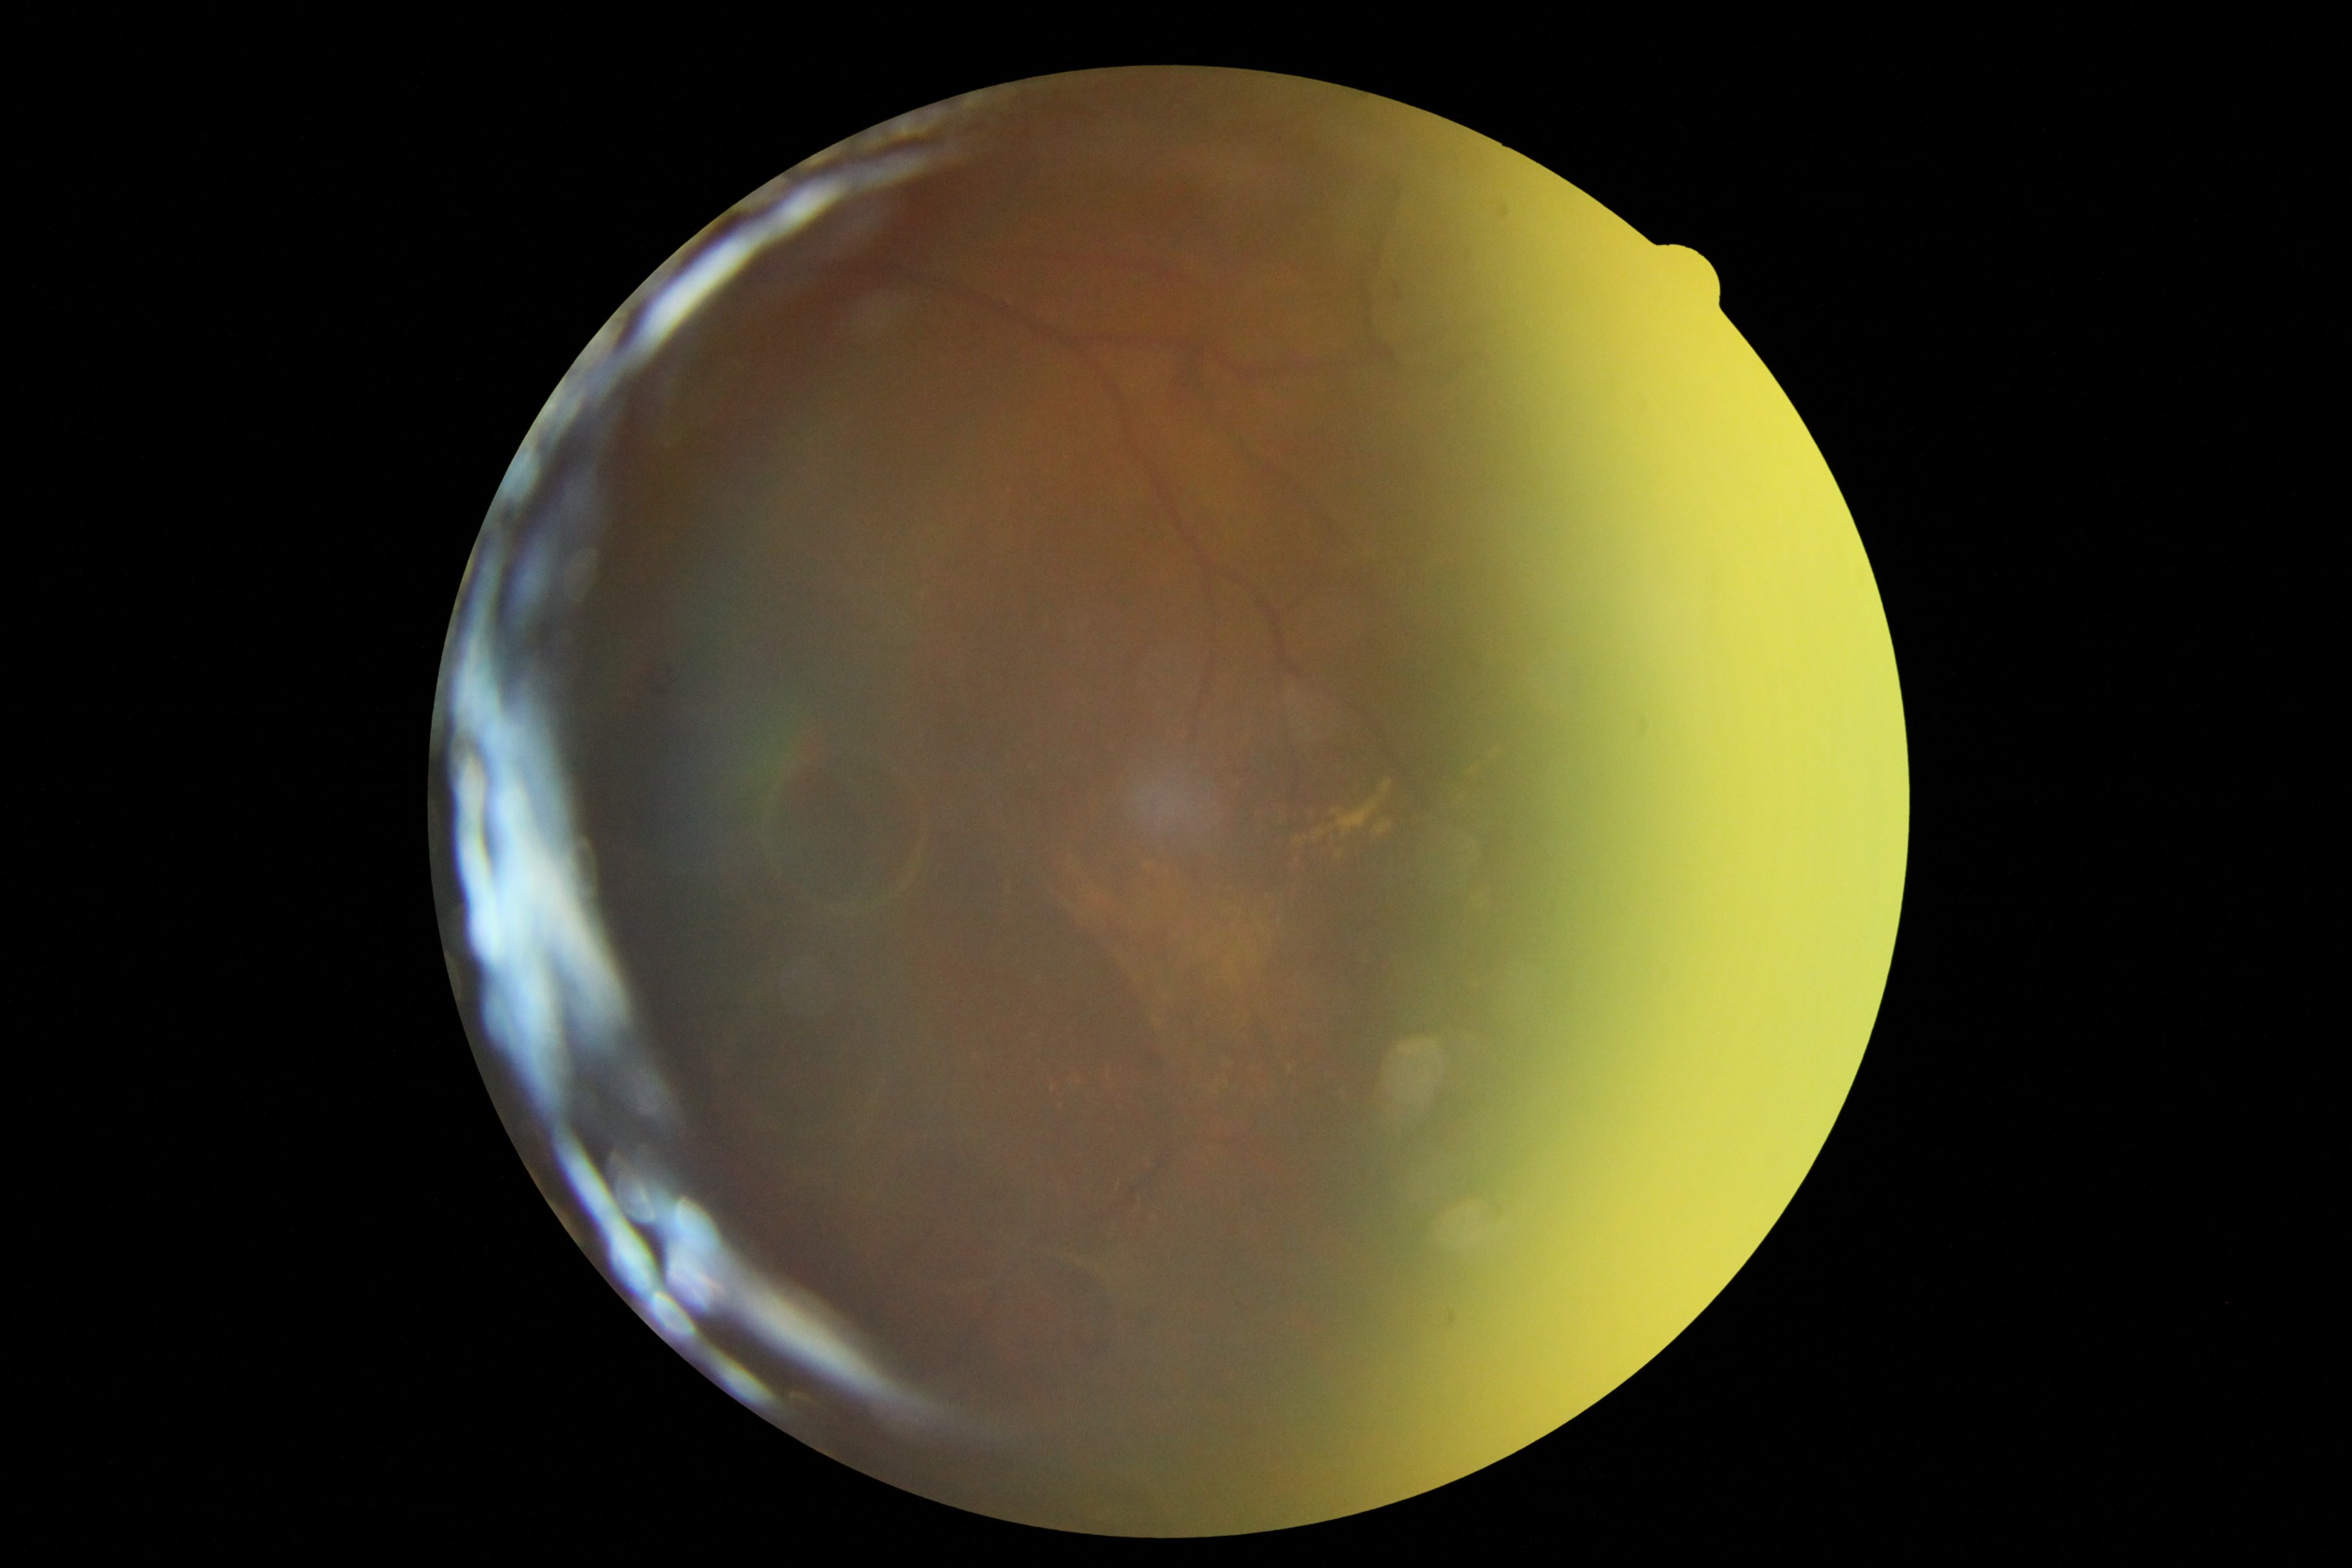

Findings:
• DR class — proliferative diabetic retinopathy
• DR severity — 4